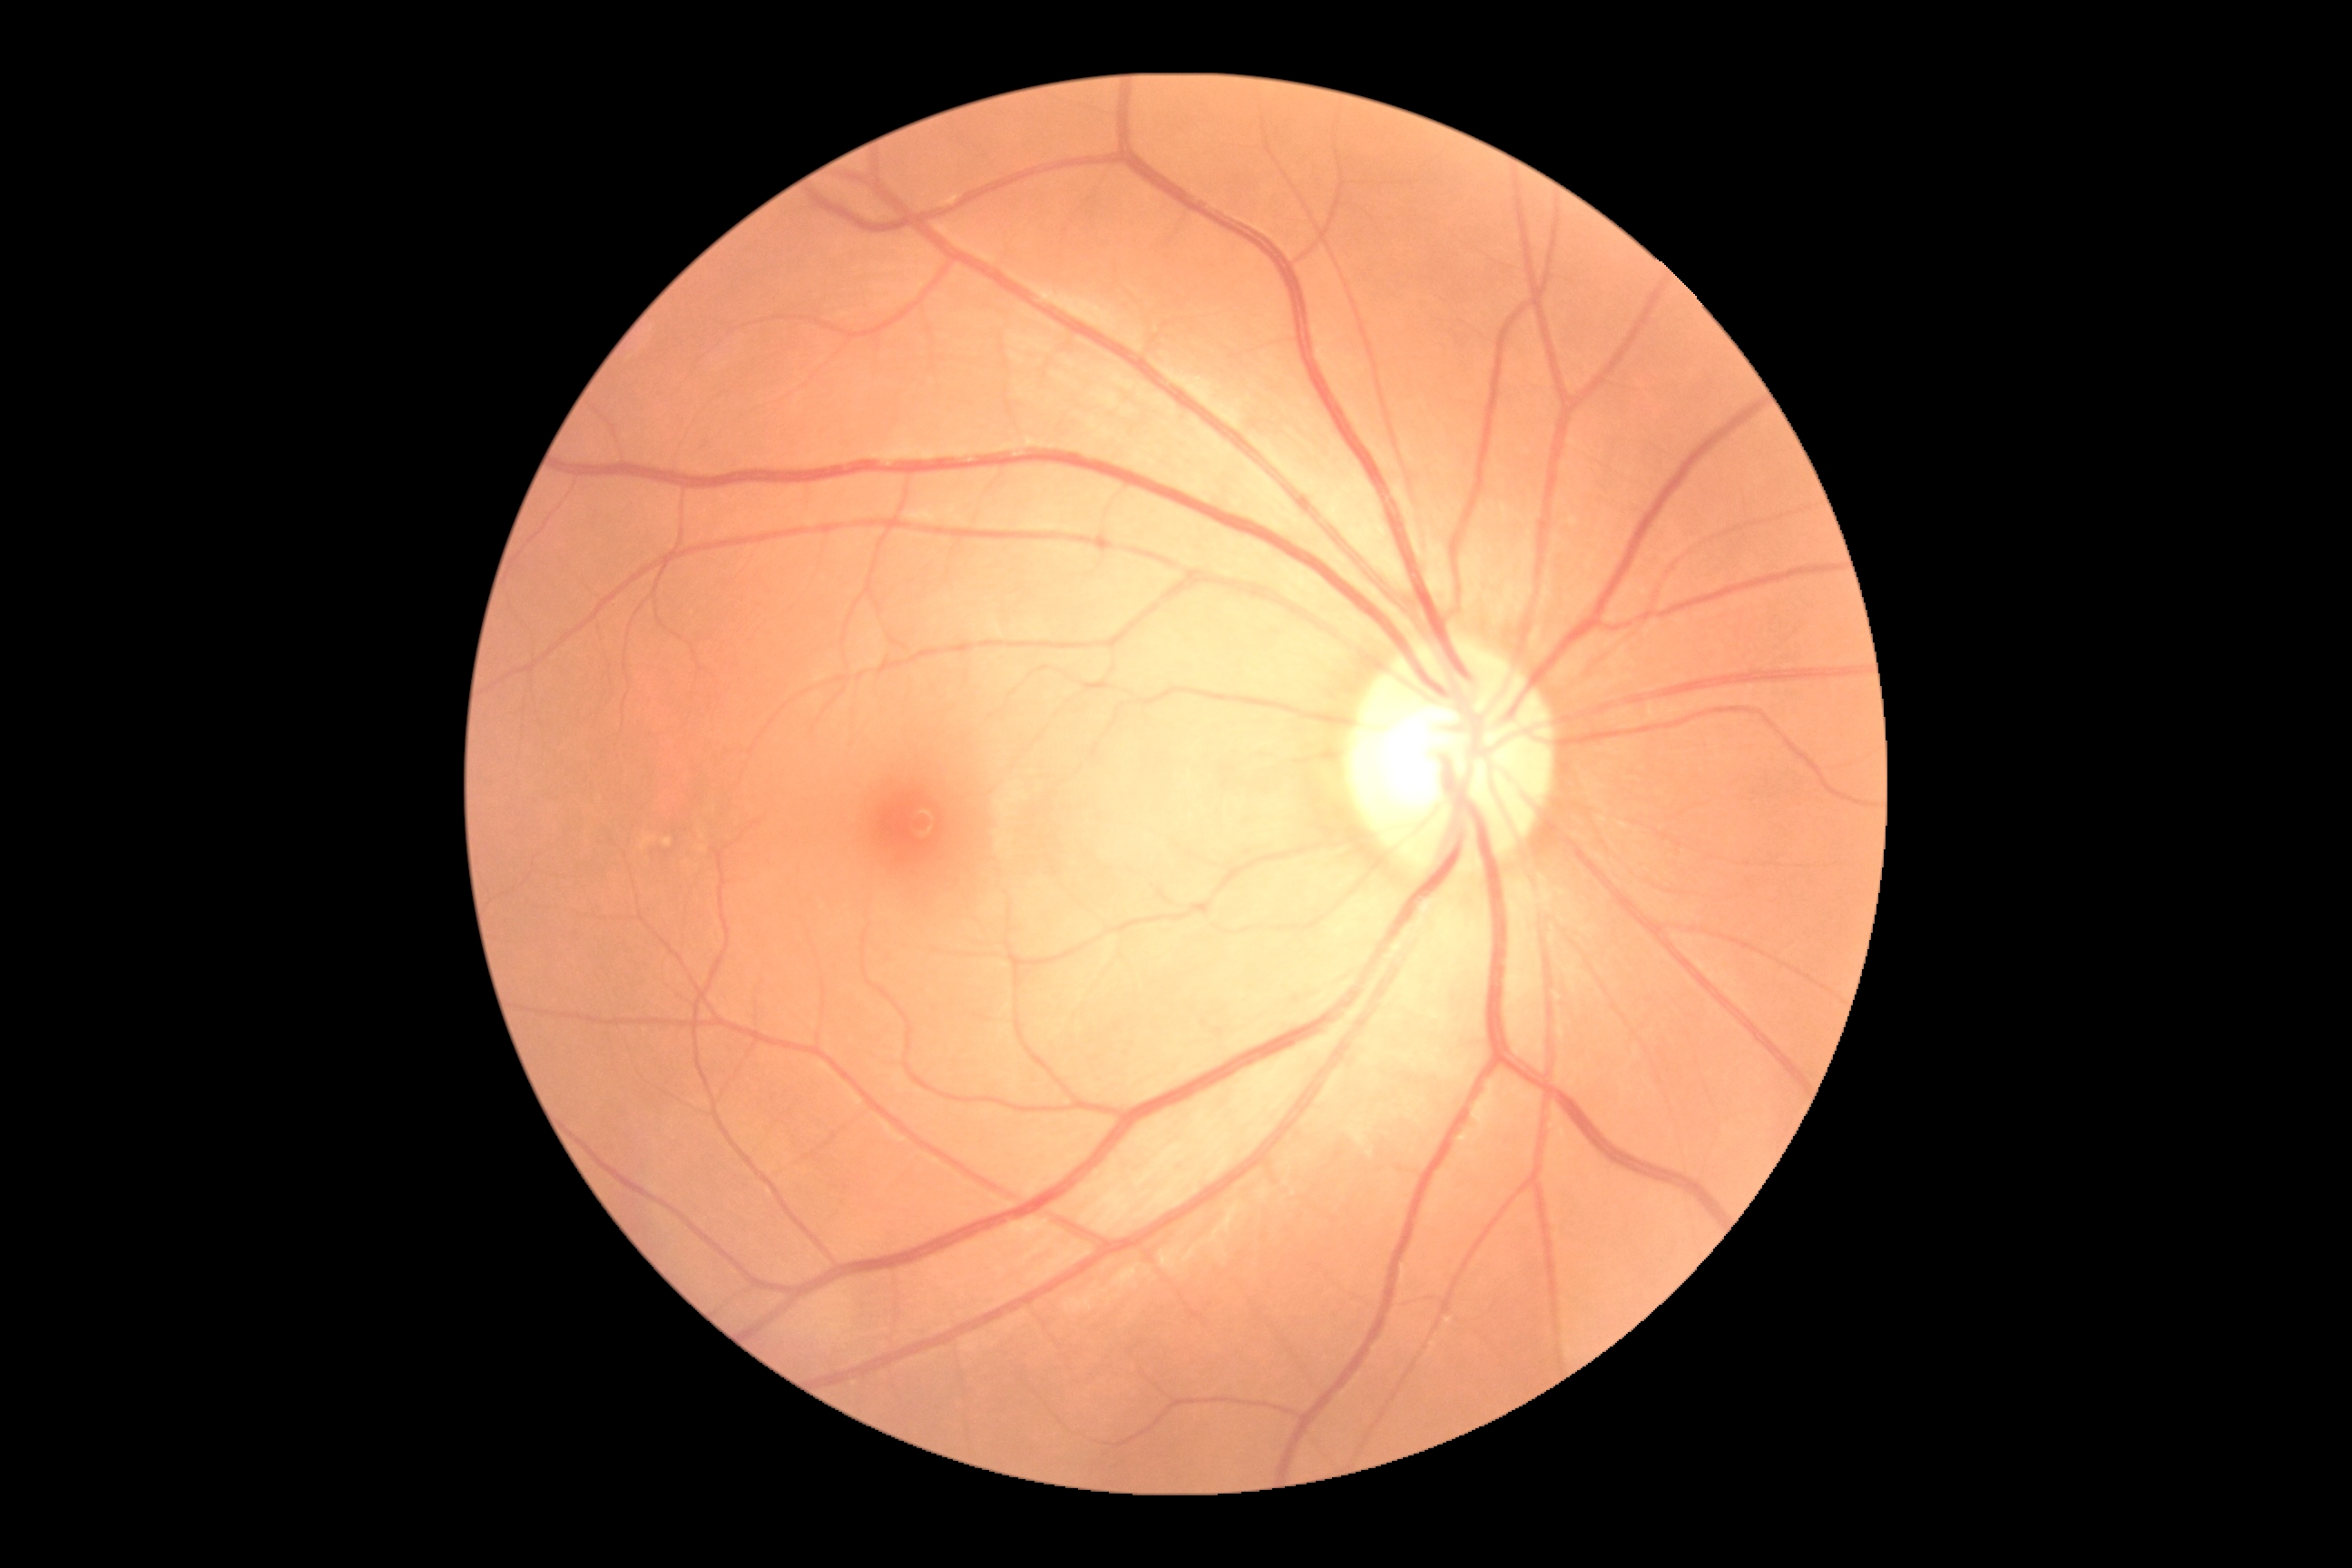
diabetic retinopathy (DR): no apparent diabetic retinopathy (grade 0).